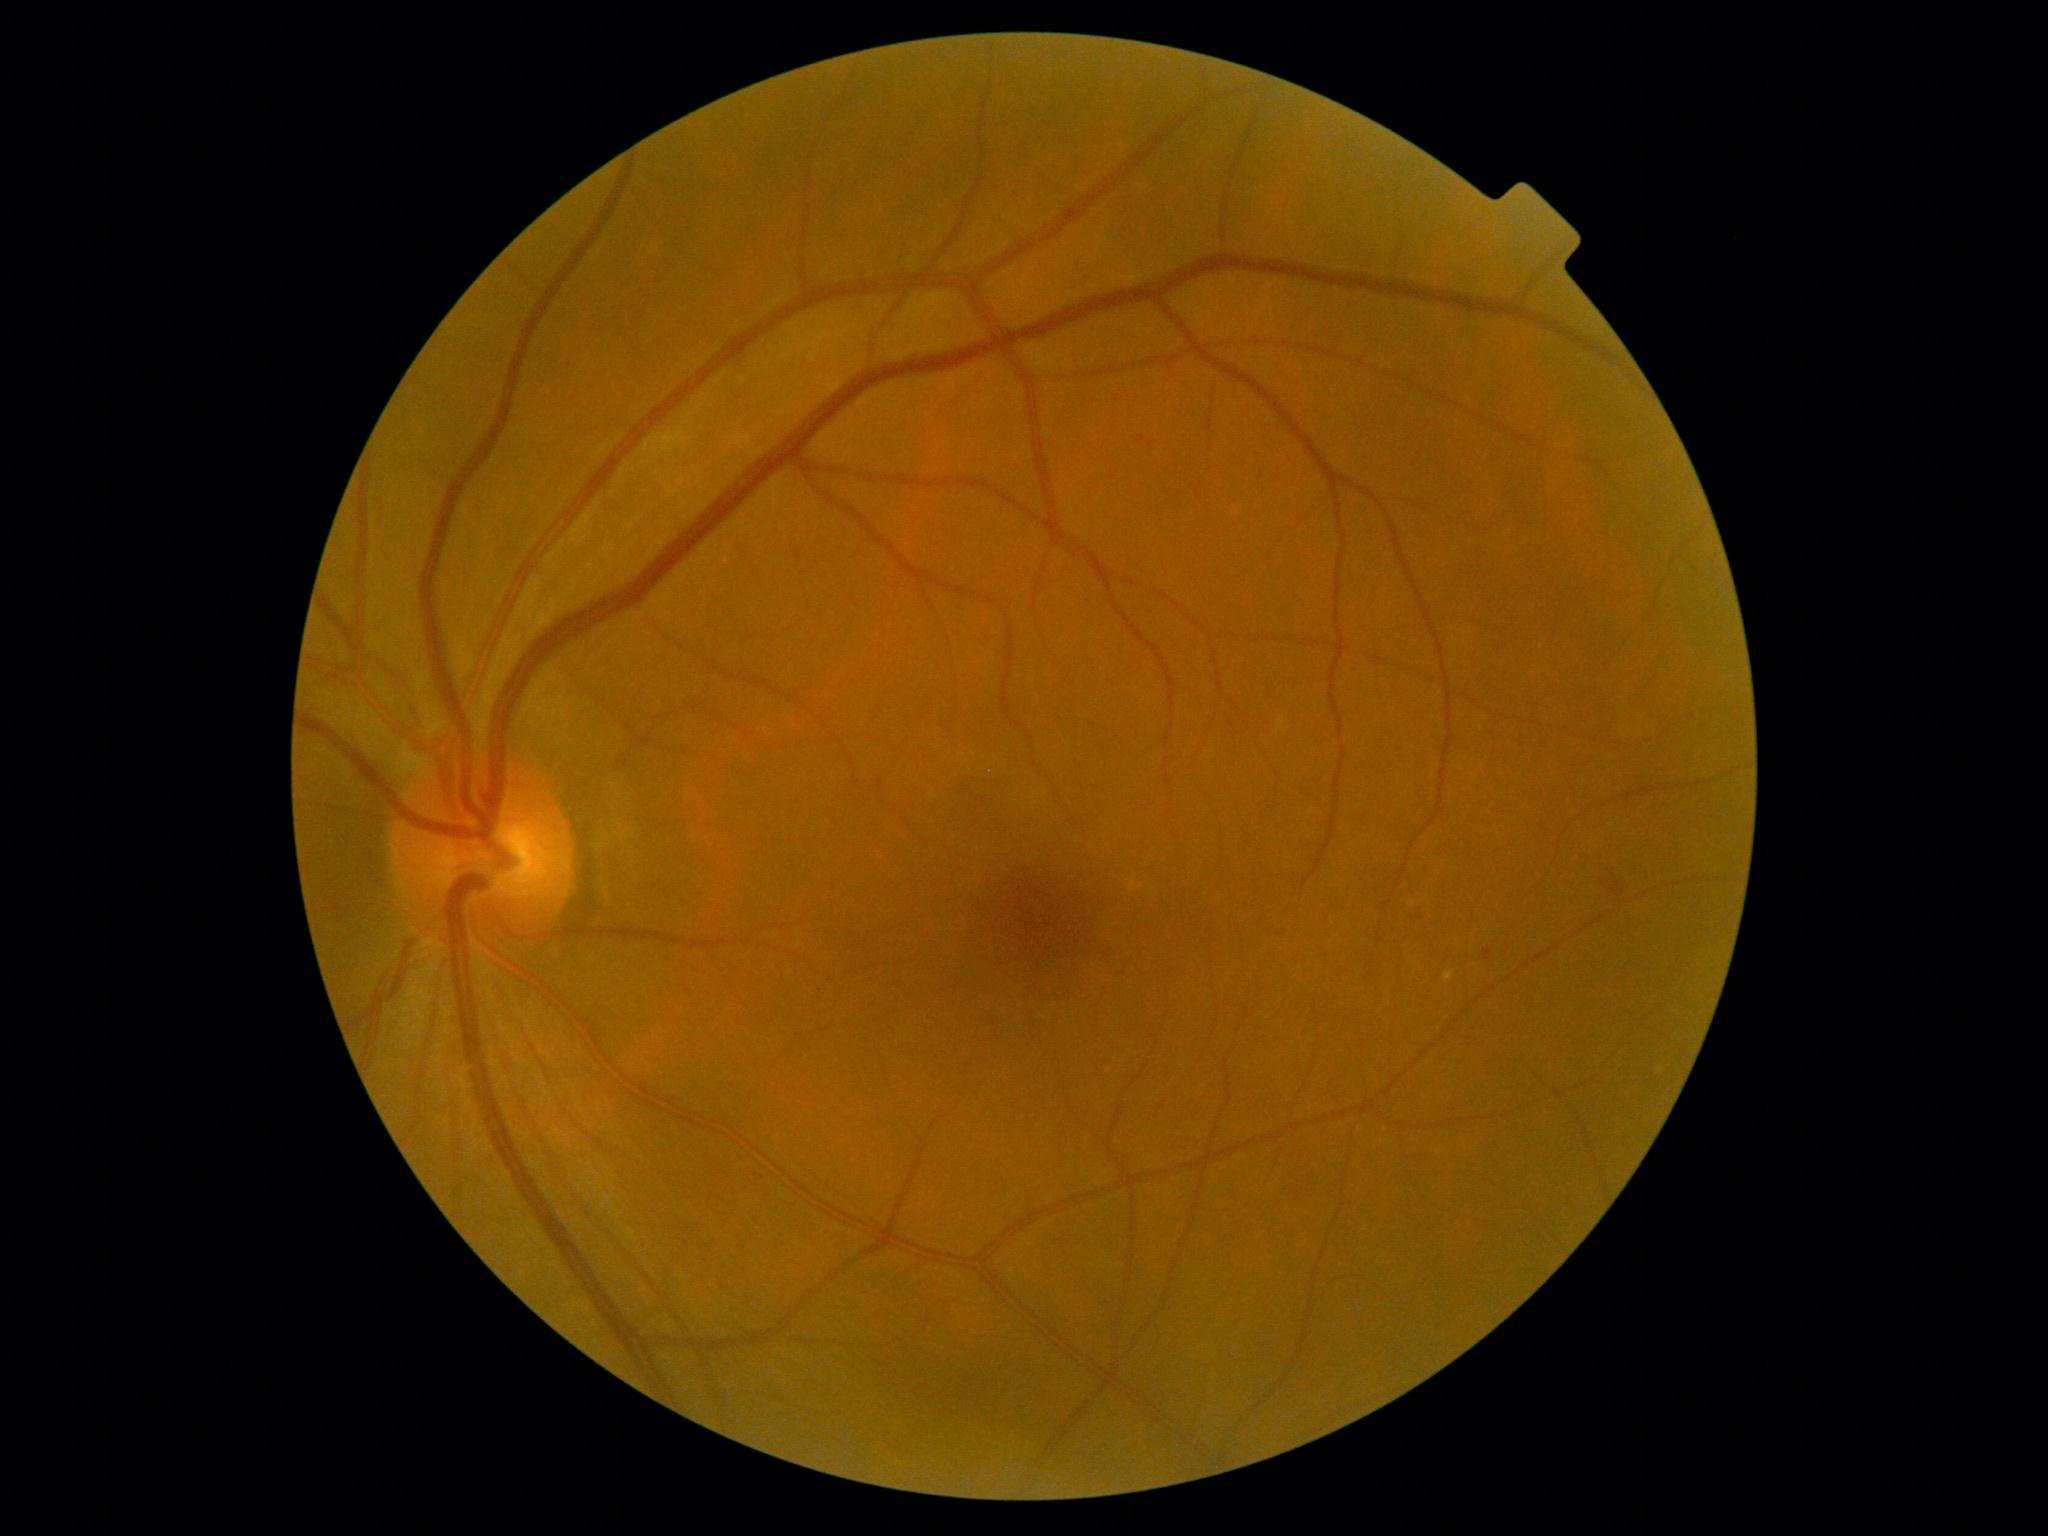
Diabetic retinopathy grade is 1 (mild NPDR).